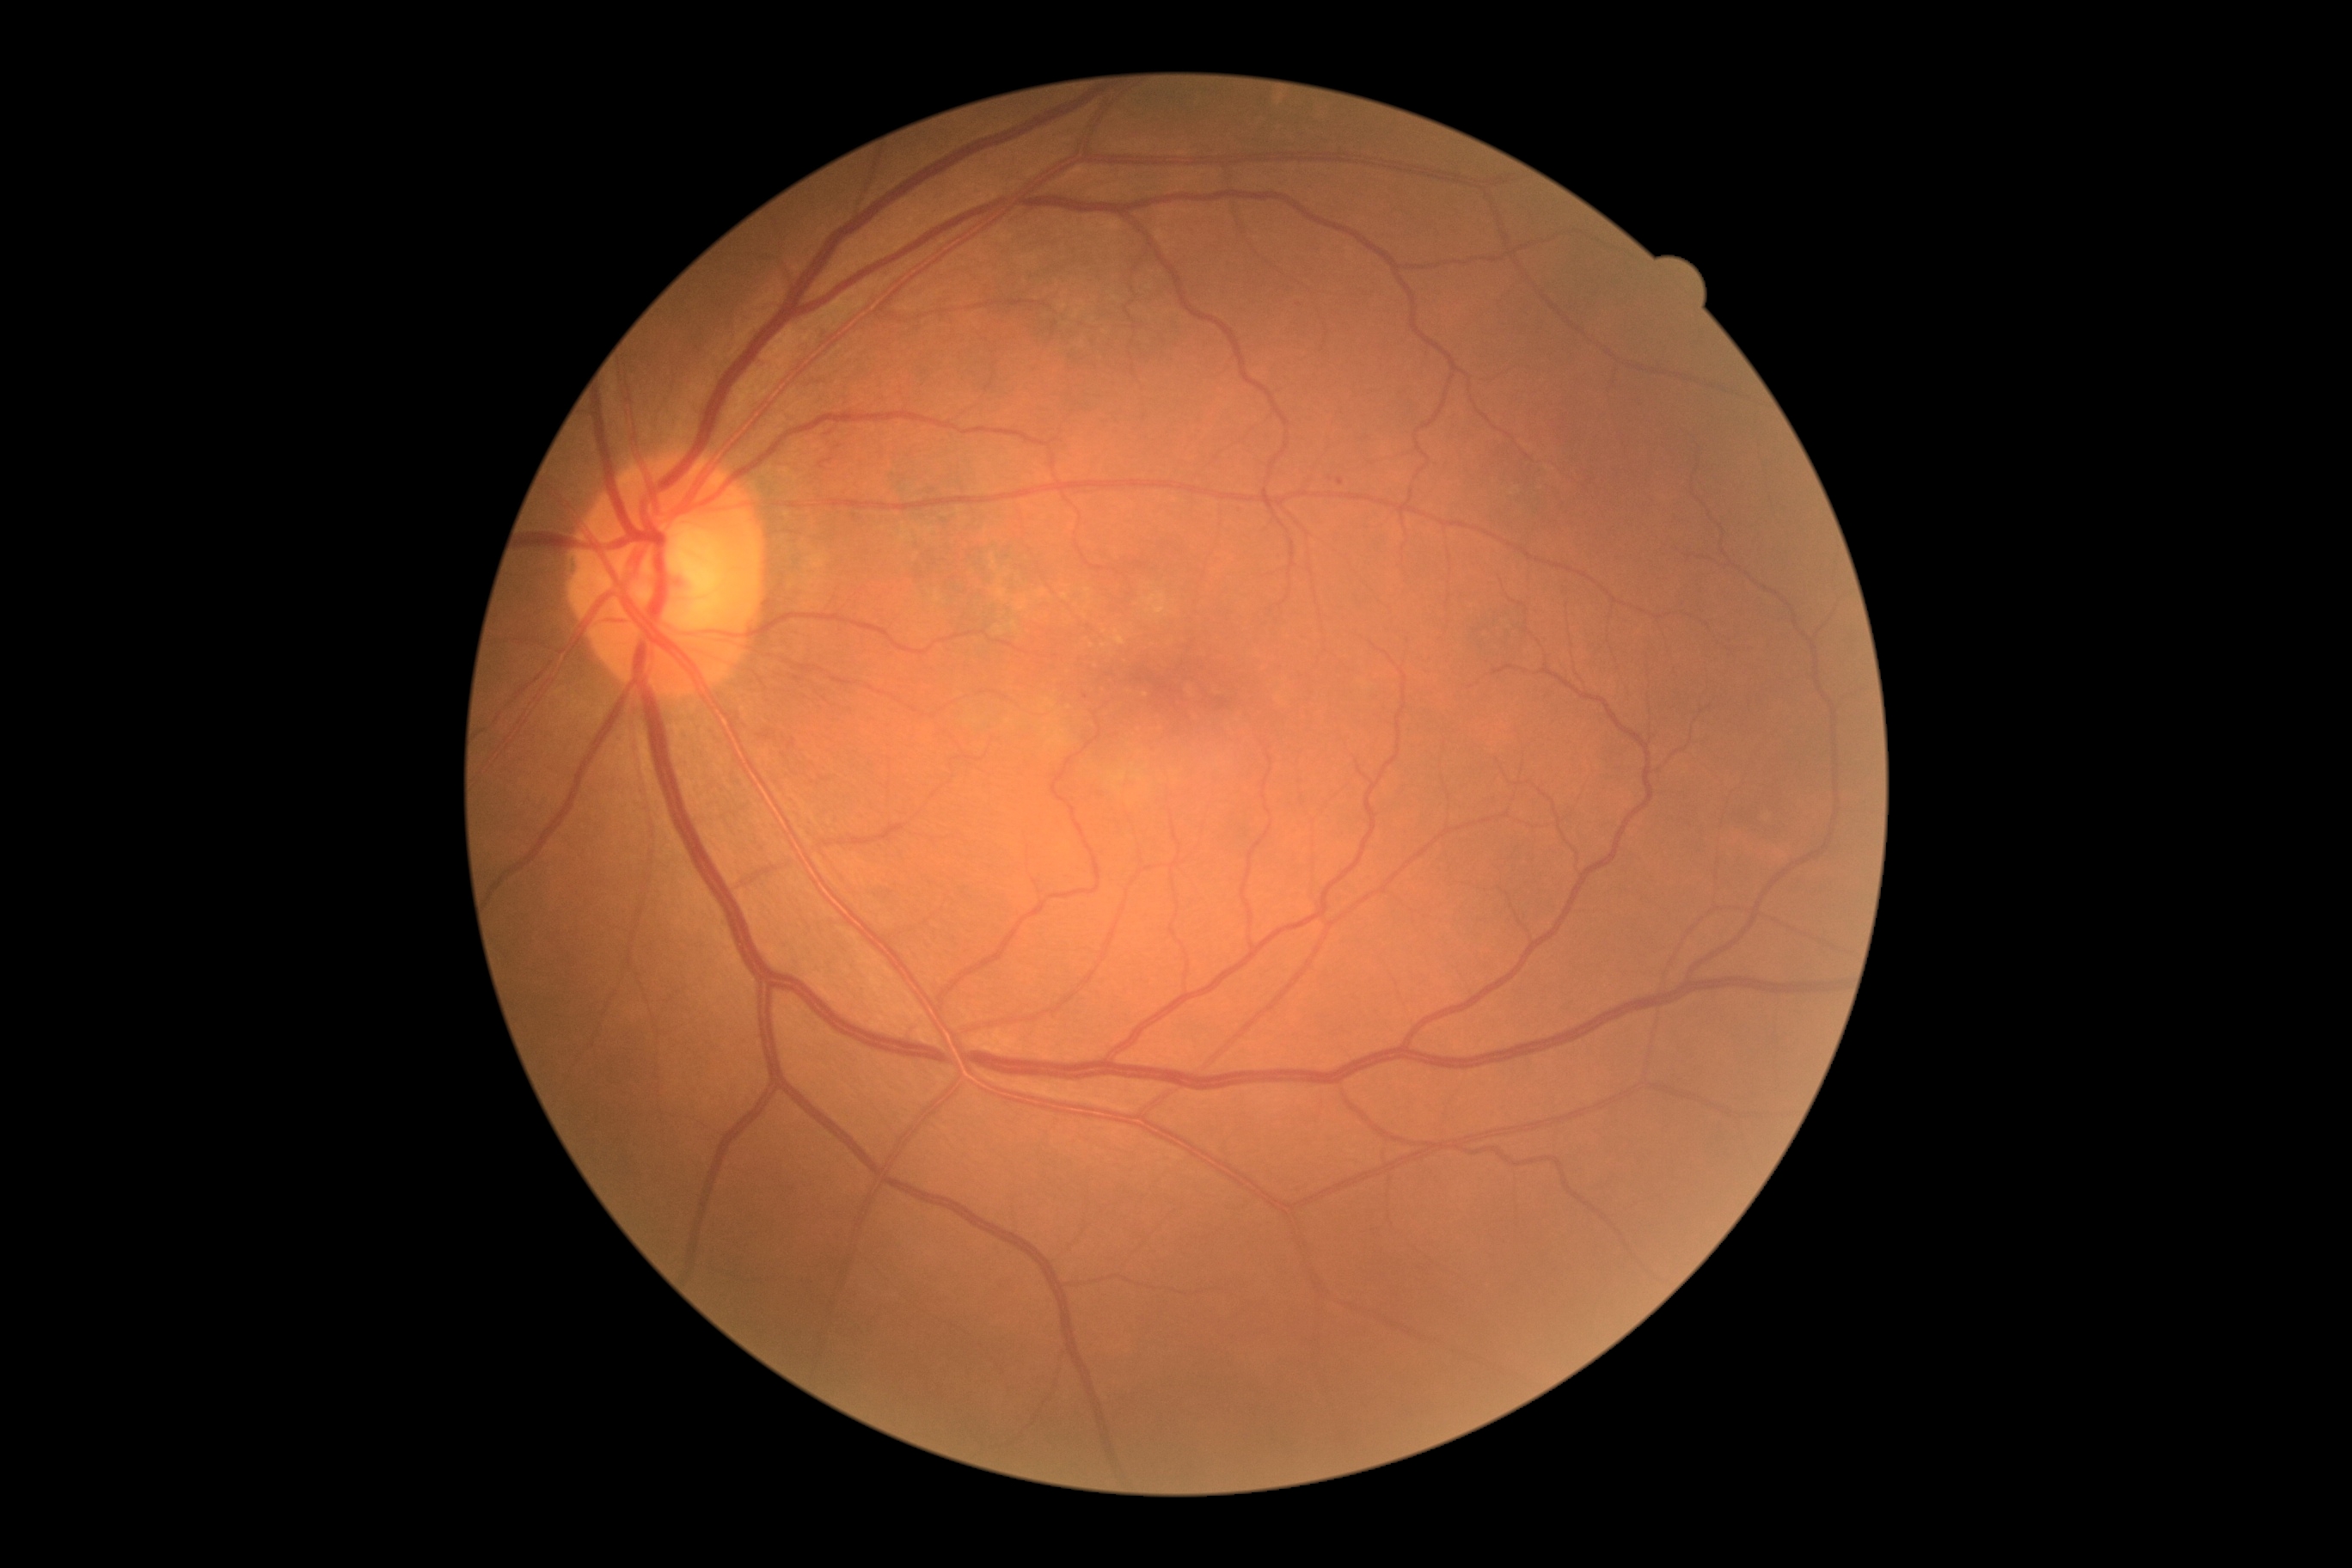

dr_grade: 1